Acquired with a NIDEK AFC-230, graded on the modified Davis scale, 848 x 848 pixels, 45 degree fundus photograph: 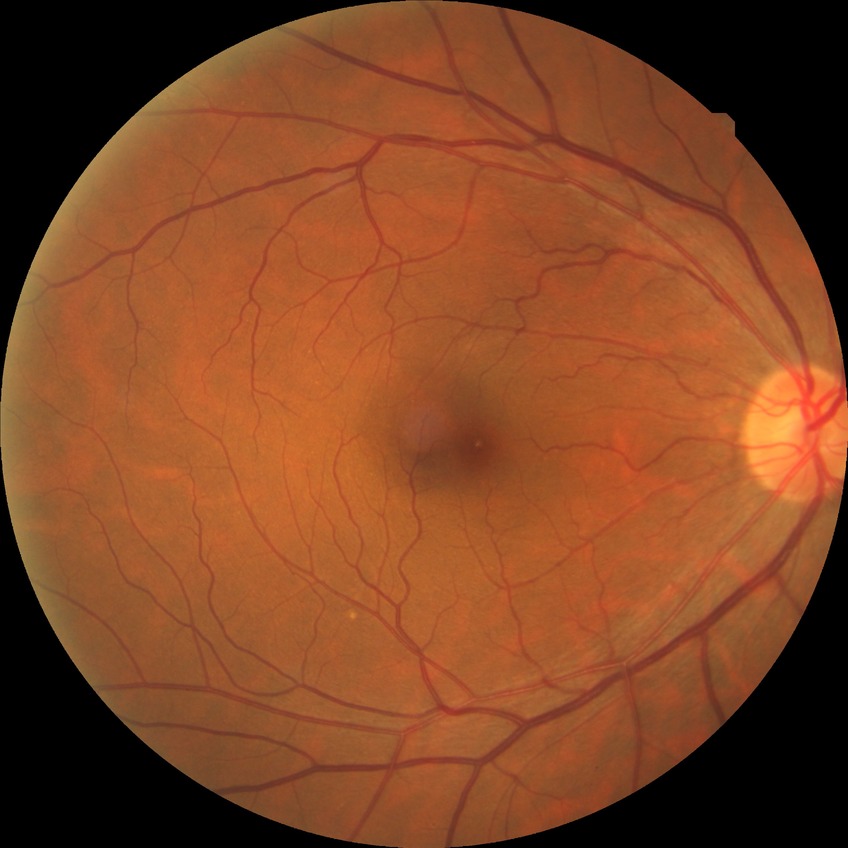 Diabetic retinopathy (DR): NDR (no diabetic retinopathy).